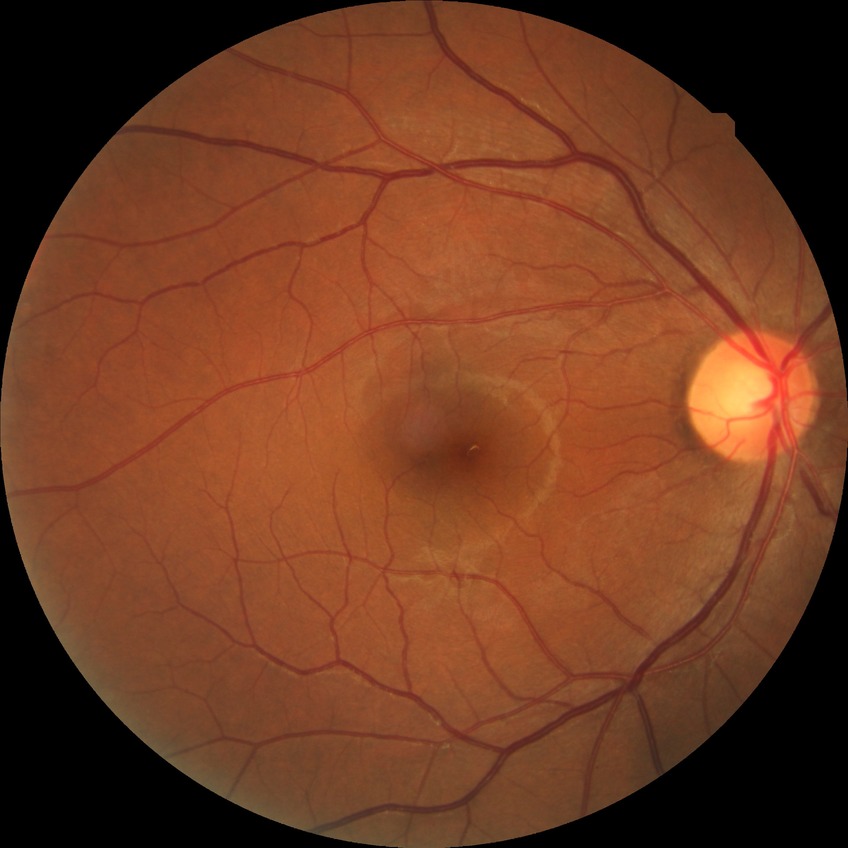 Diabetic retinopathy (DR) is NDR (no diabetic retinopathy).